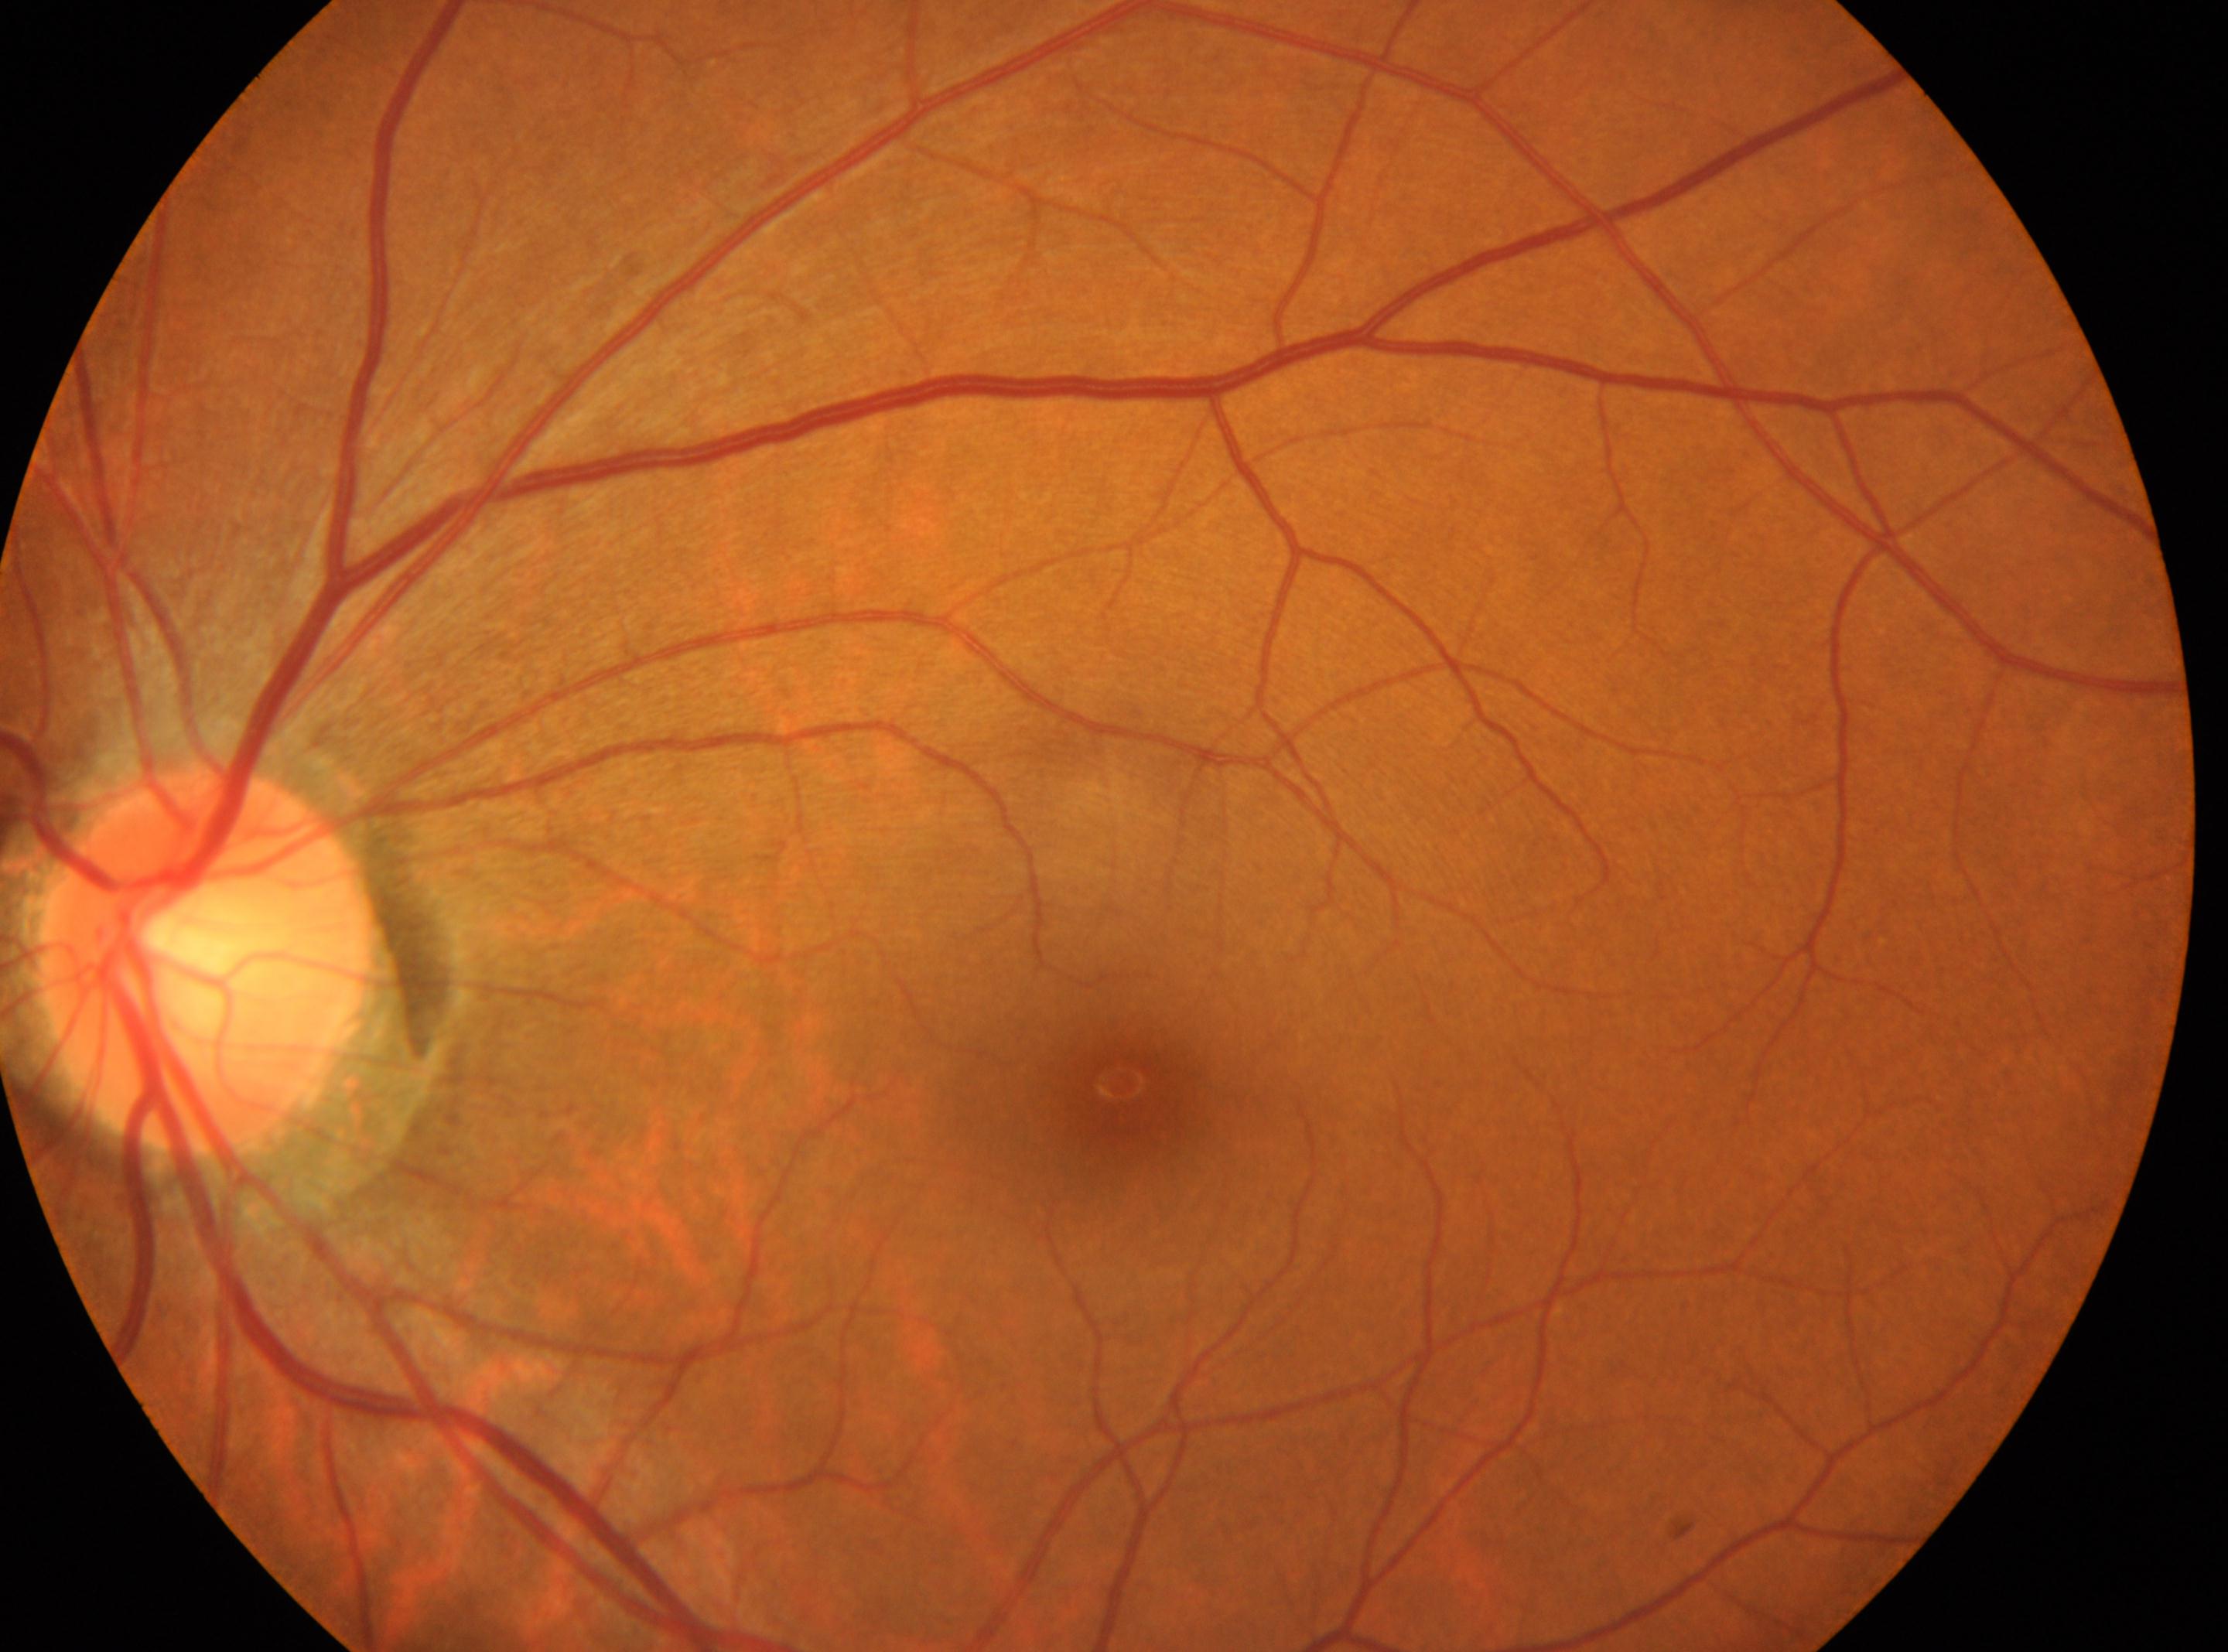
Eye: left. ONH: (207,957). The macula center is at (1119,1081). DR severity: grade 0.